Color fundus image — 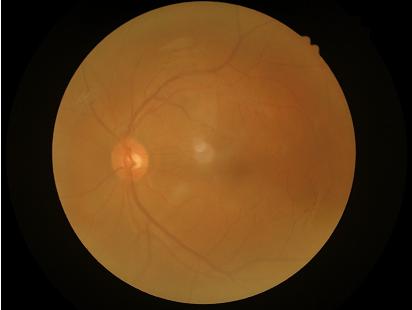

Image quality: contrast: narrow intensity range, structures hard to distinguish; focus: noticeable blur in the optic disc, vessels, or background; overall: poor and difficult to use diagnostically.